1932x1910px
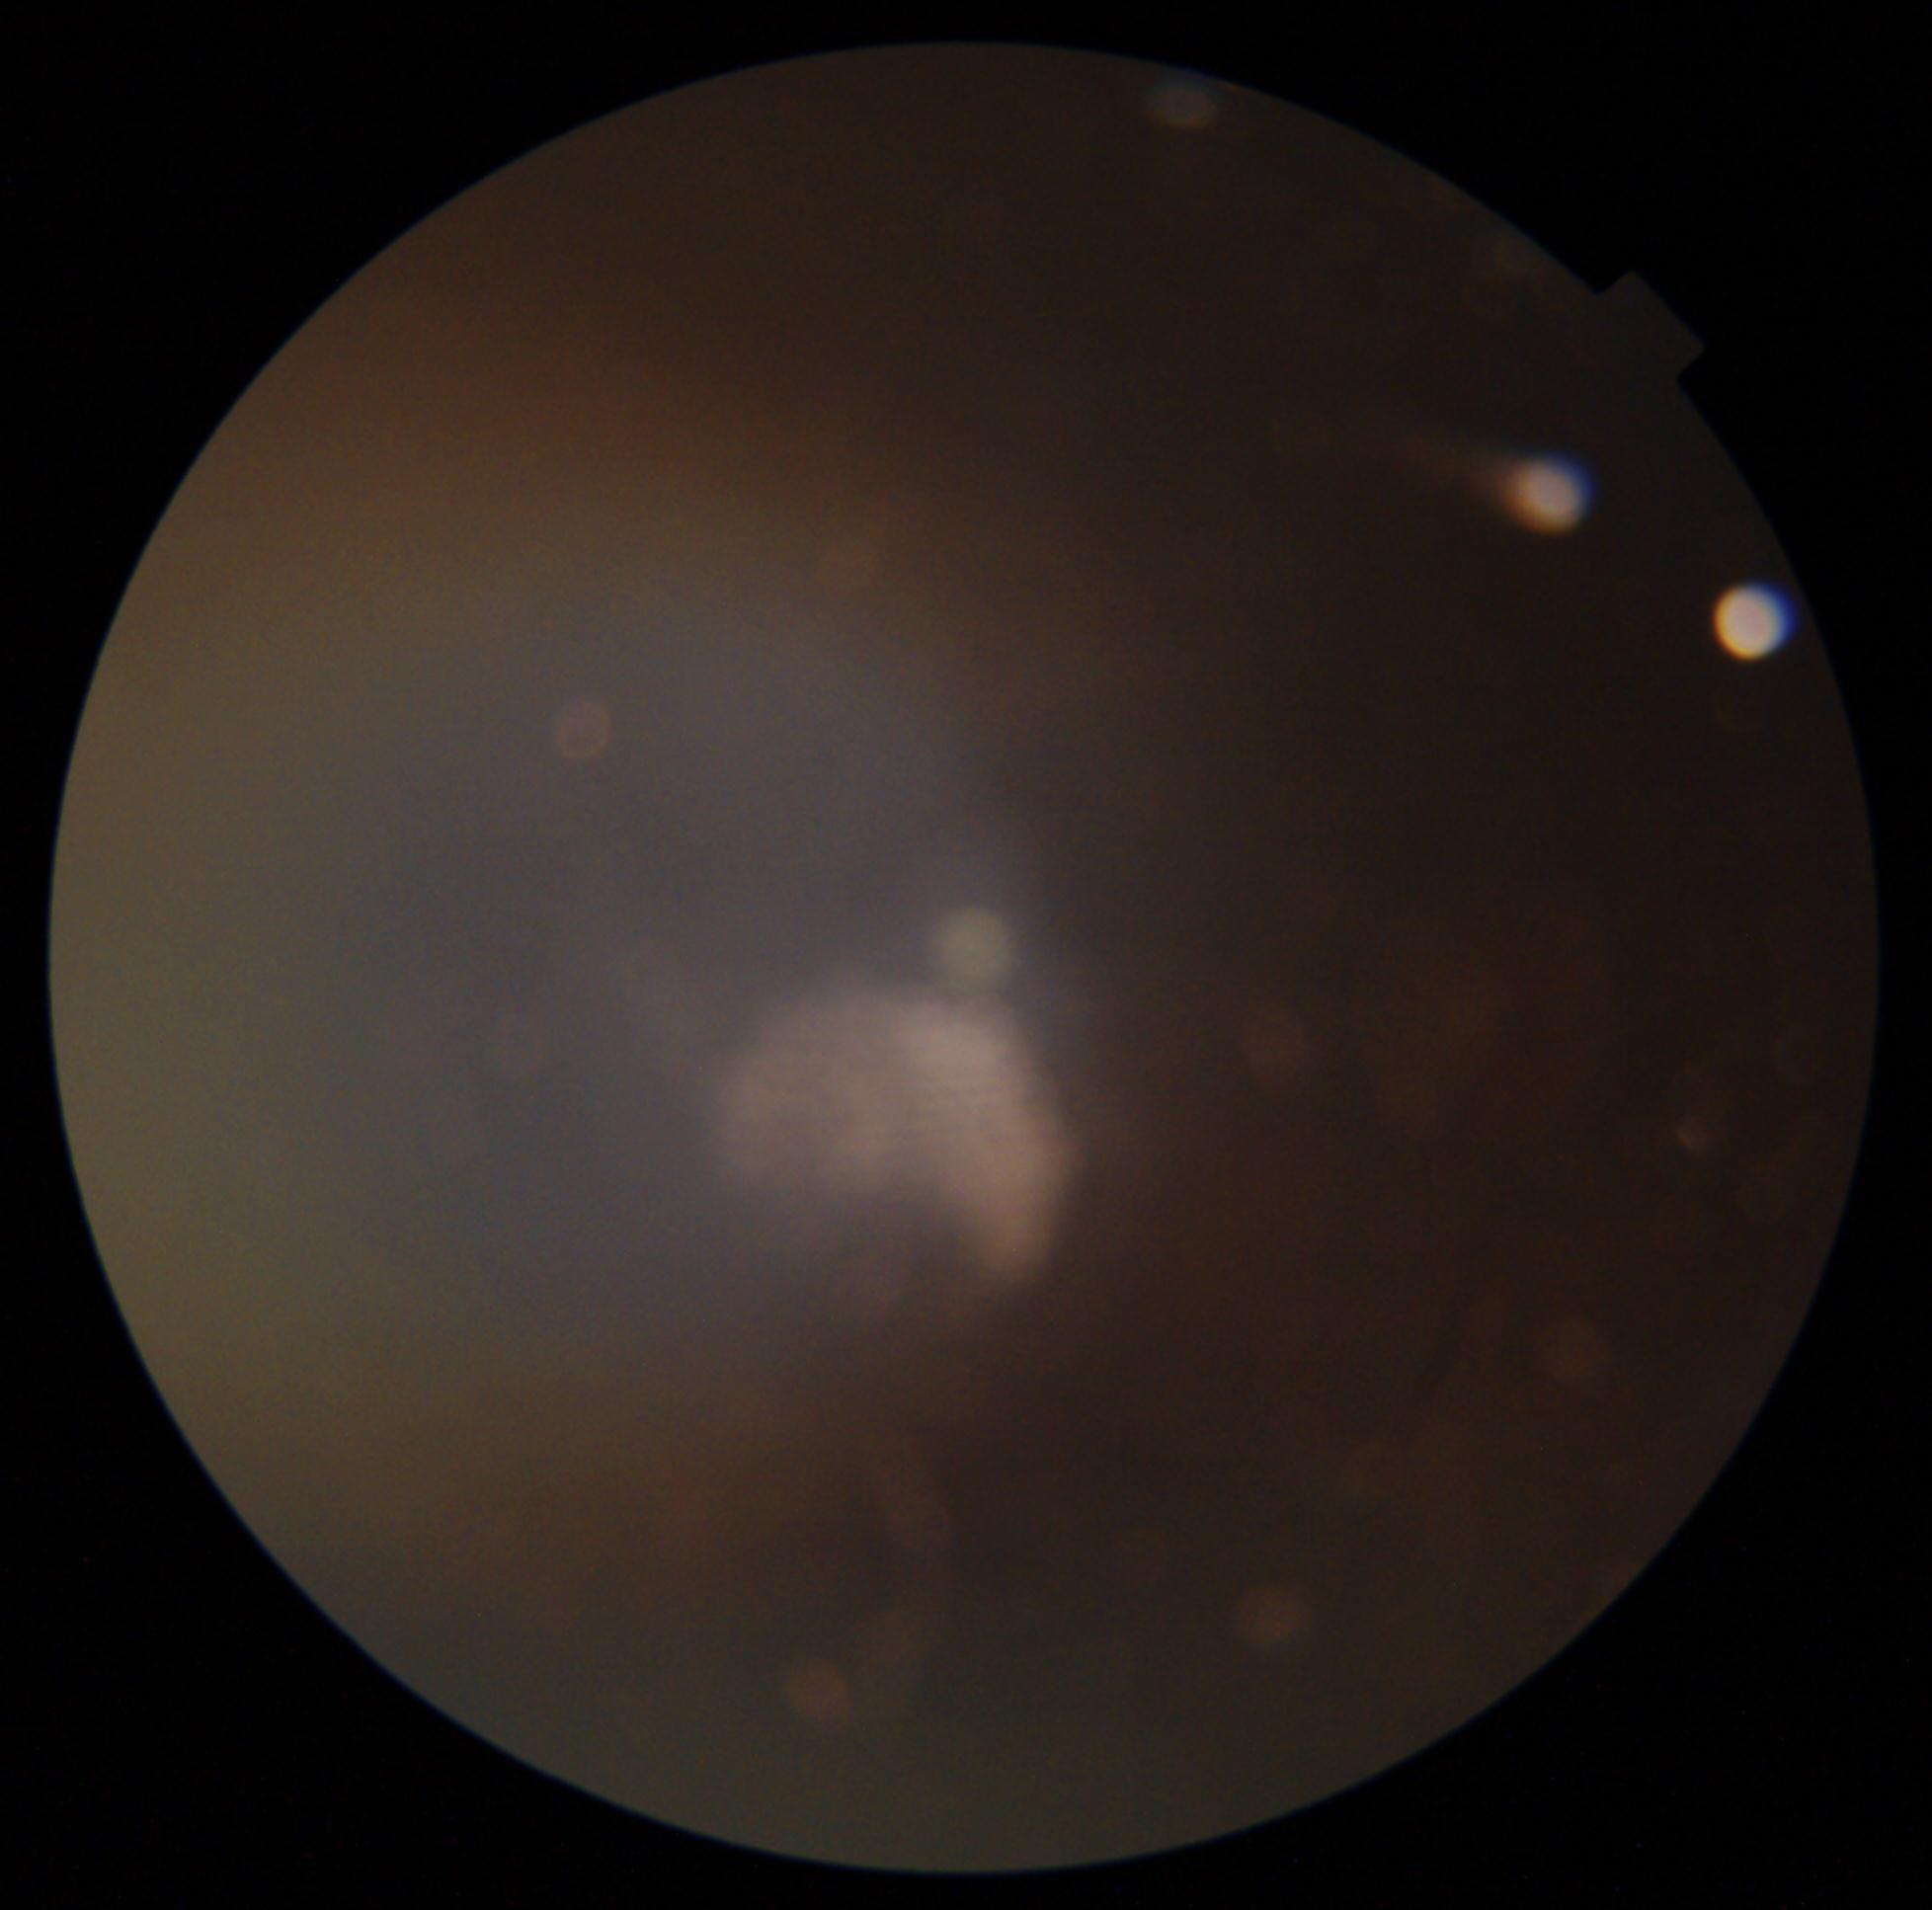

Diabetic retinopathy grade is ungradable due to poor image quality.